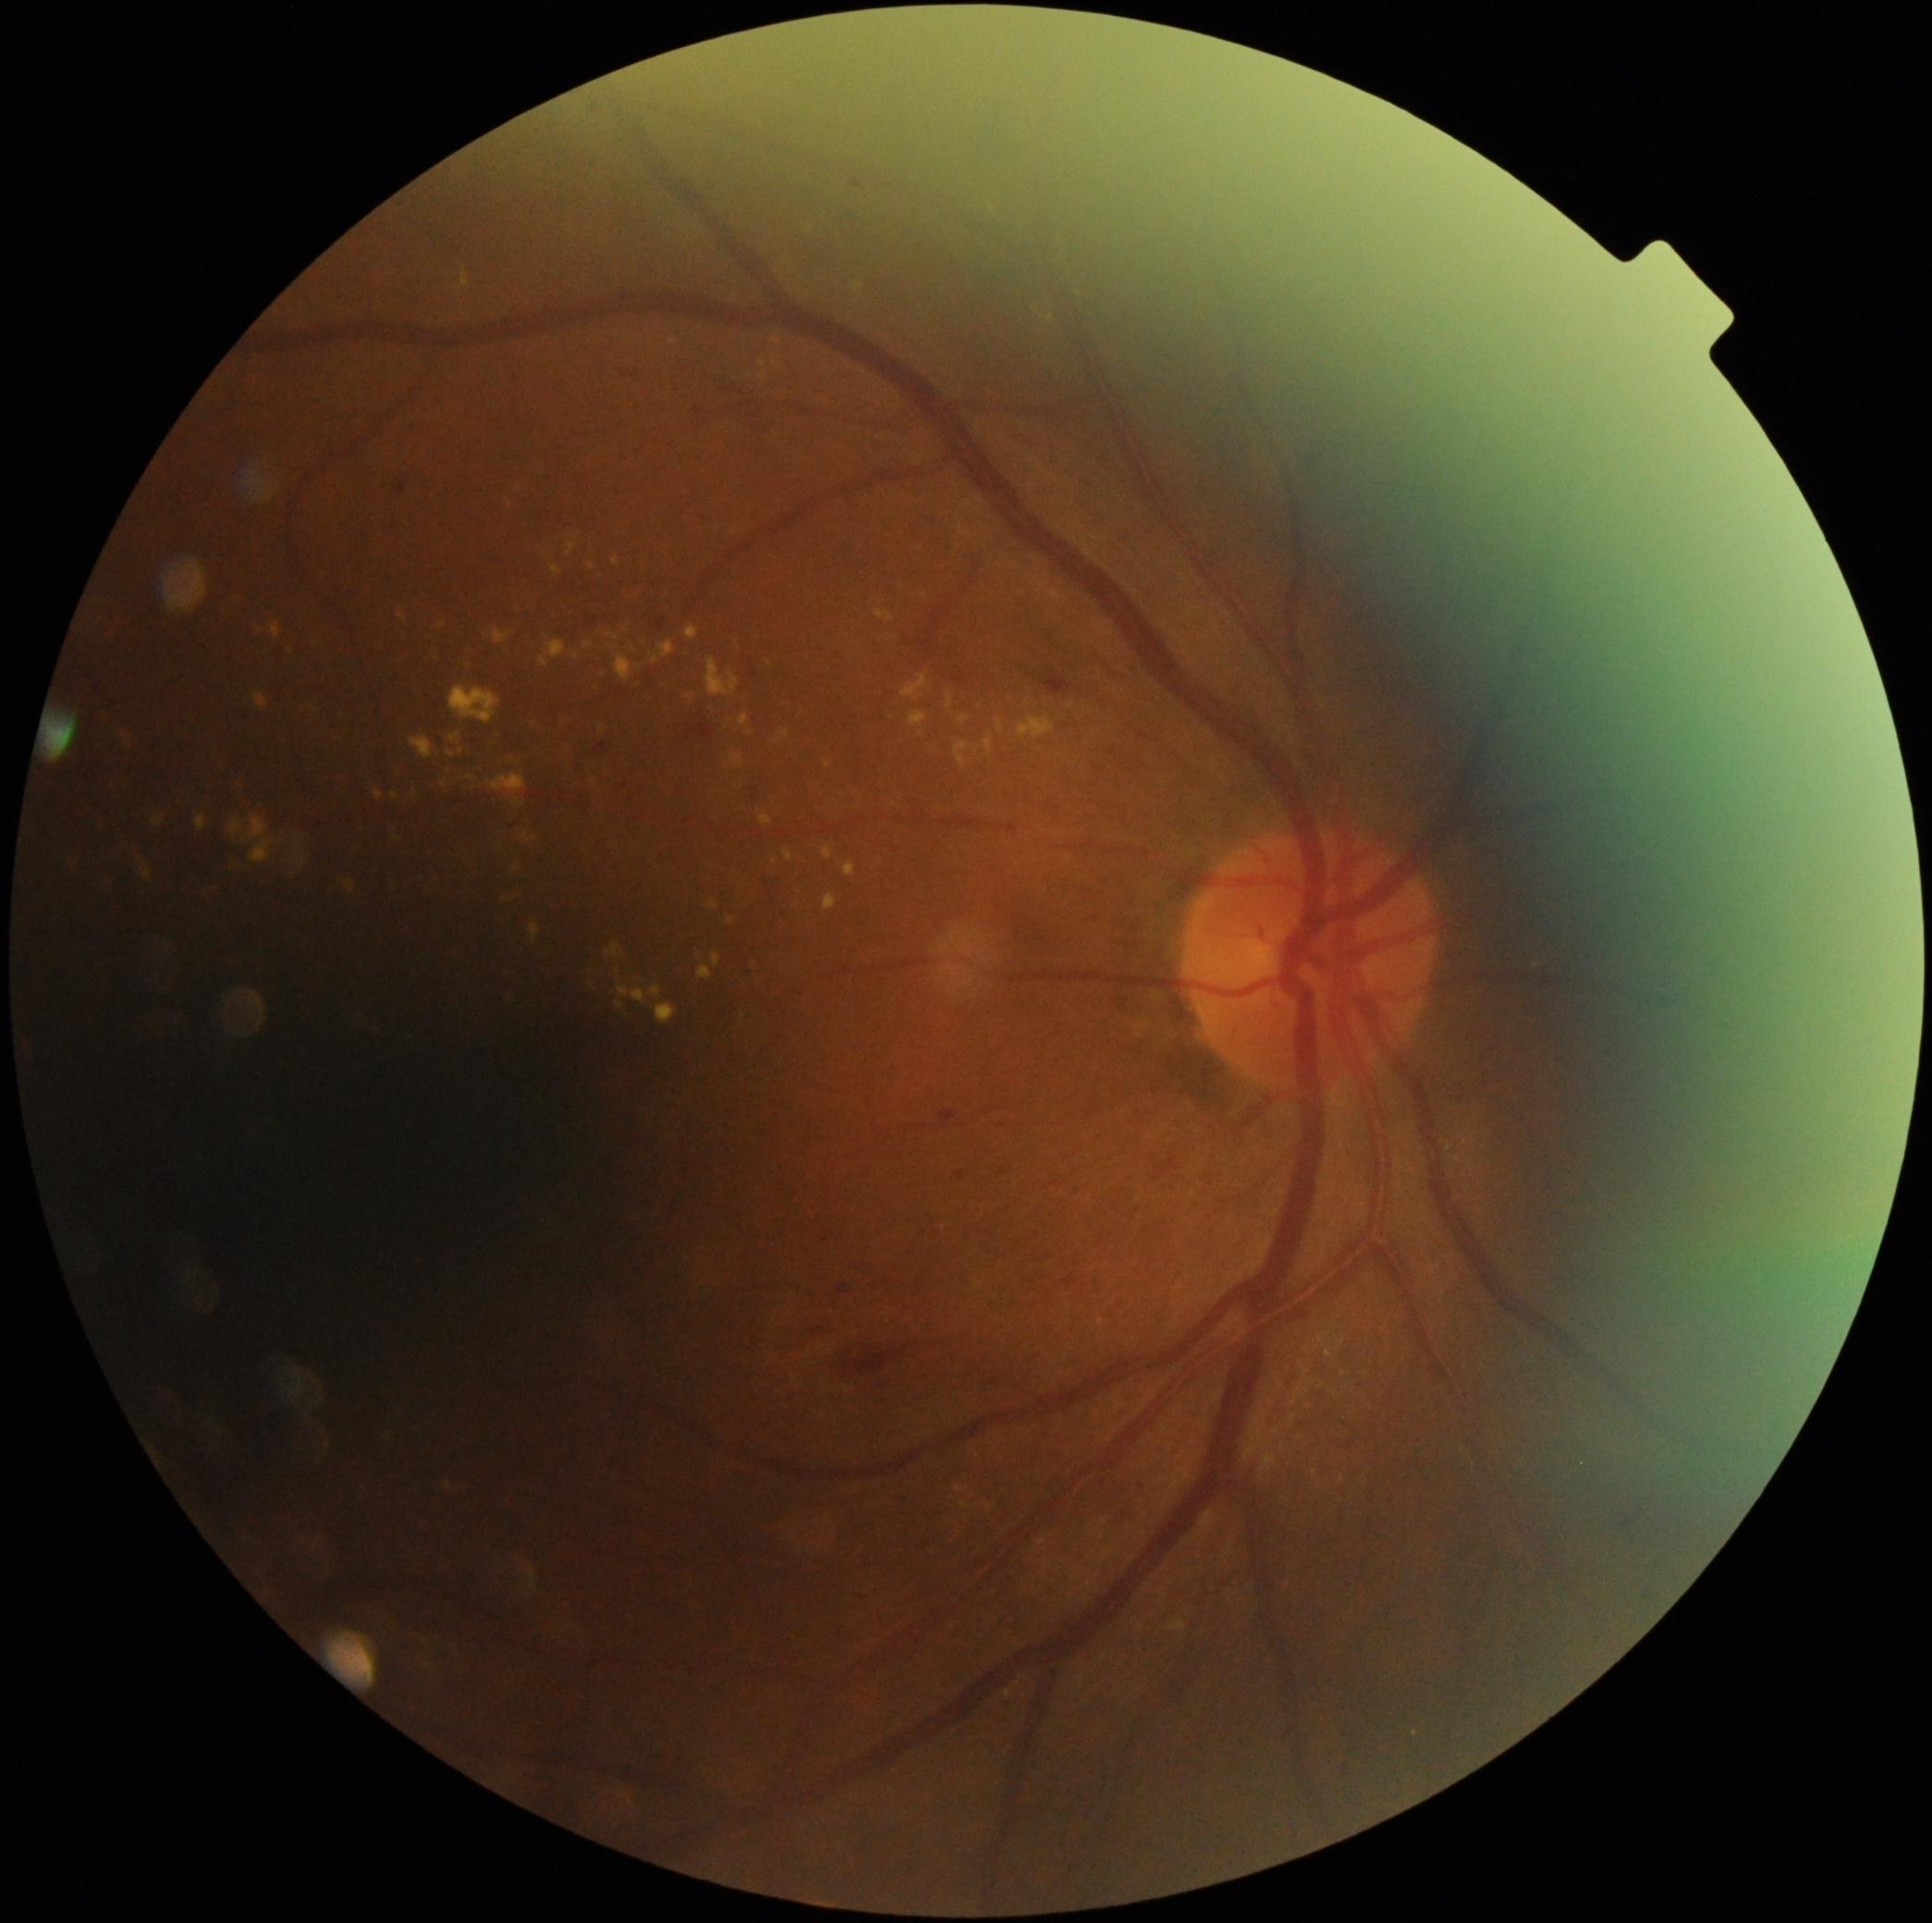 <lesions partial="true">
  <dr_grade>2</dr_grade>
  <ex partial="true">x1=486 y1=629 x2=513 y2=645, x1=96 y1=815 x2=105 y2=828, x1=69 y1=862 x2=78 y2=871, x1=504 y1=757 x2=519 y2=766, x1=374 y1=790 x2=384 y2=801, x1=987 y1=1504 x2=993 y2=1513, x1=197 y1=815 x2=208 y2=832, x1=731 y1=752 x2=744 y2=768, x1=618 y1=1000 x2=625 y2=1010, x1=552 y1=567 x2=561 y2=576, x1=823 y1=847 x2=834 y2=860, x1=658 y1=642 x2=676 y2=658, x1=539 y1=640 x2=567 y2=668</ex>
  <ex_small_centers>[x=689, y=697], [x=921, y=735], [x=518, y=489], [x=602, y=729], [x=749, y=376], [x=776, y=364]</ex_small_centers>
</lesions>